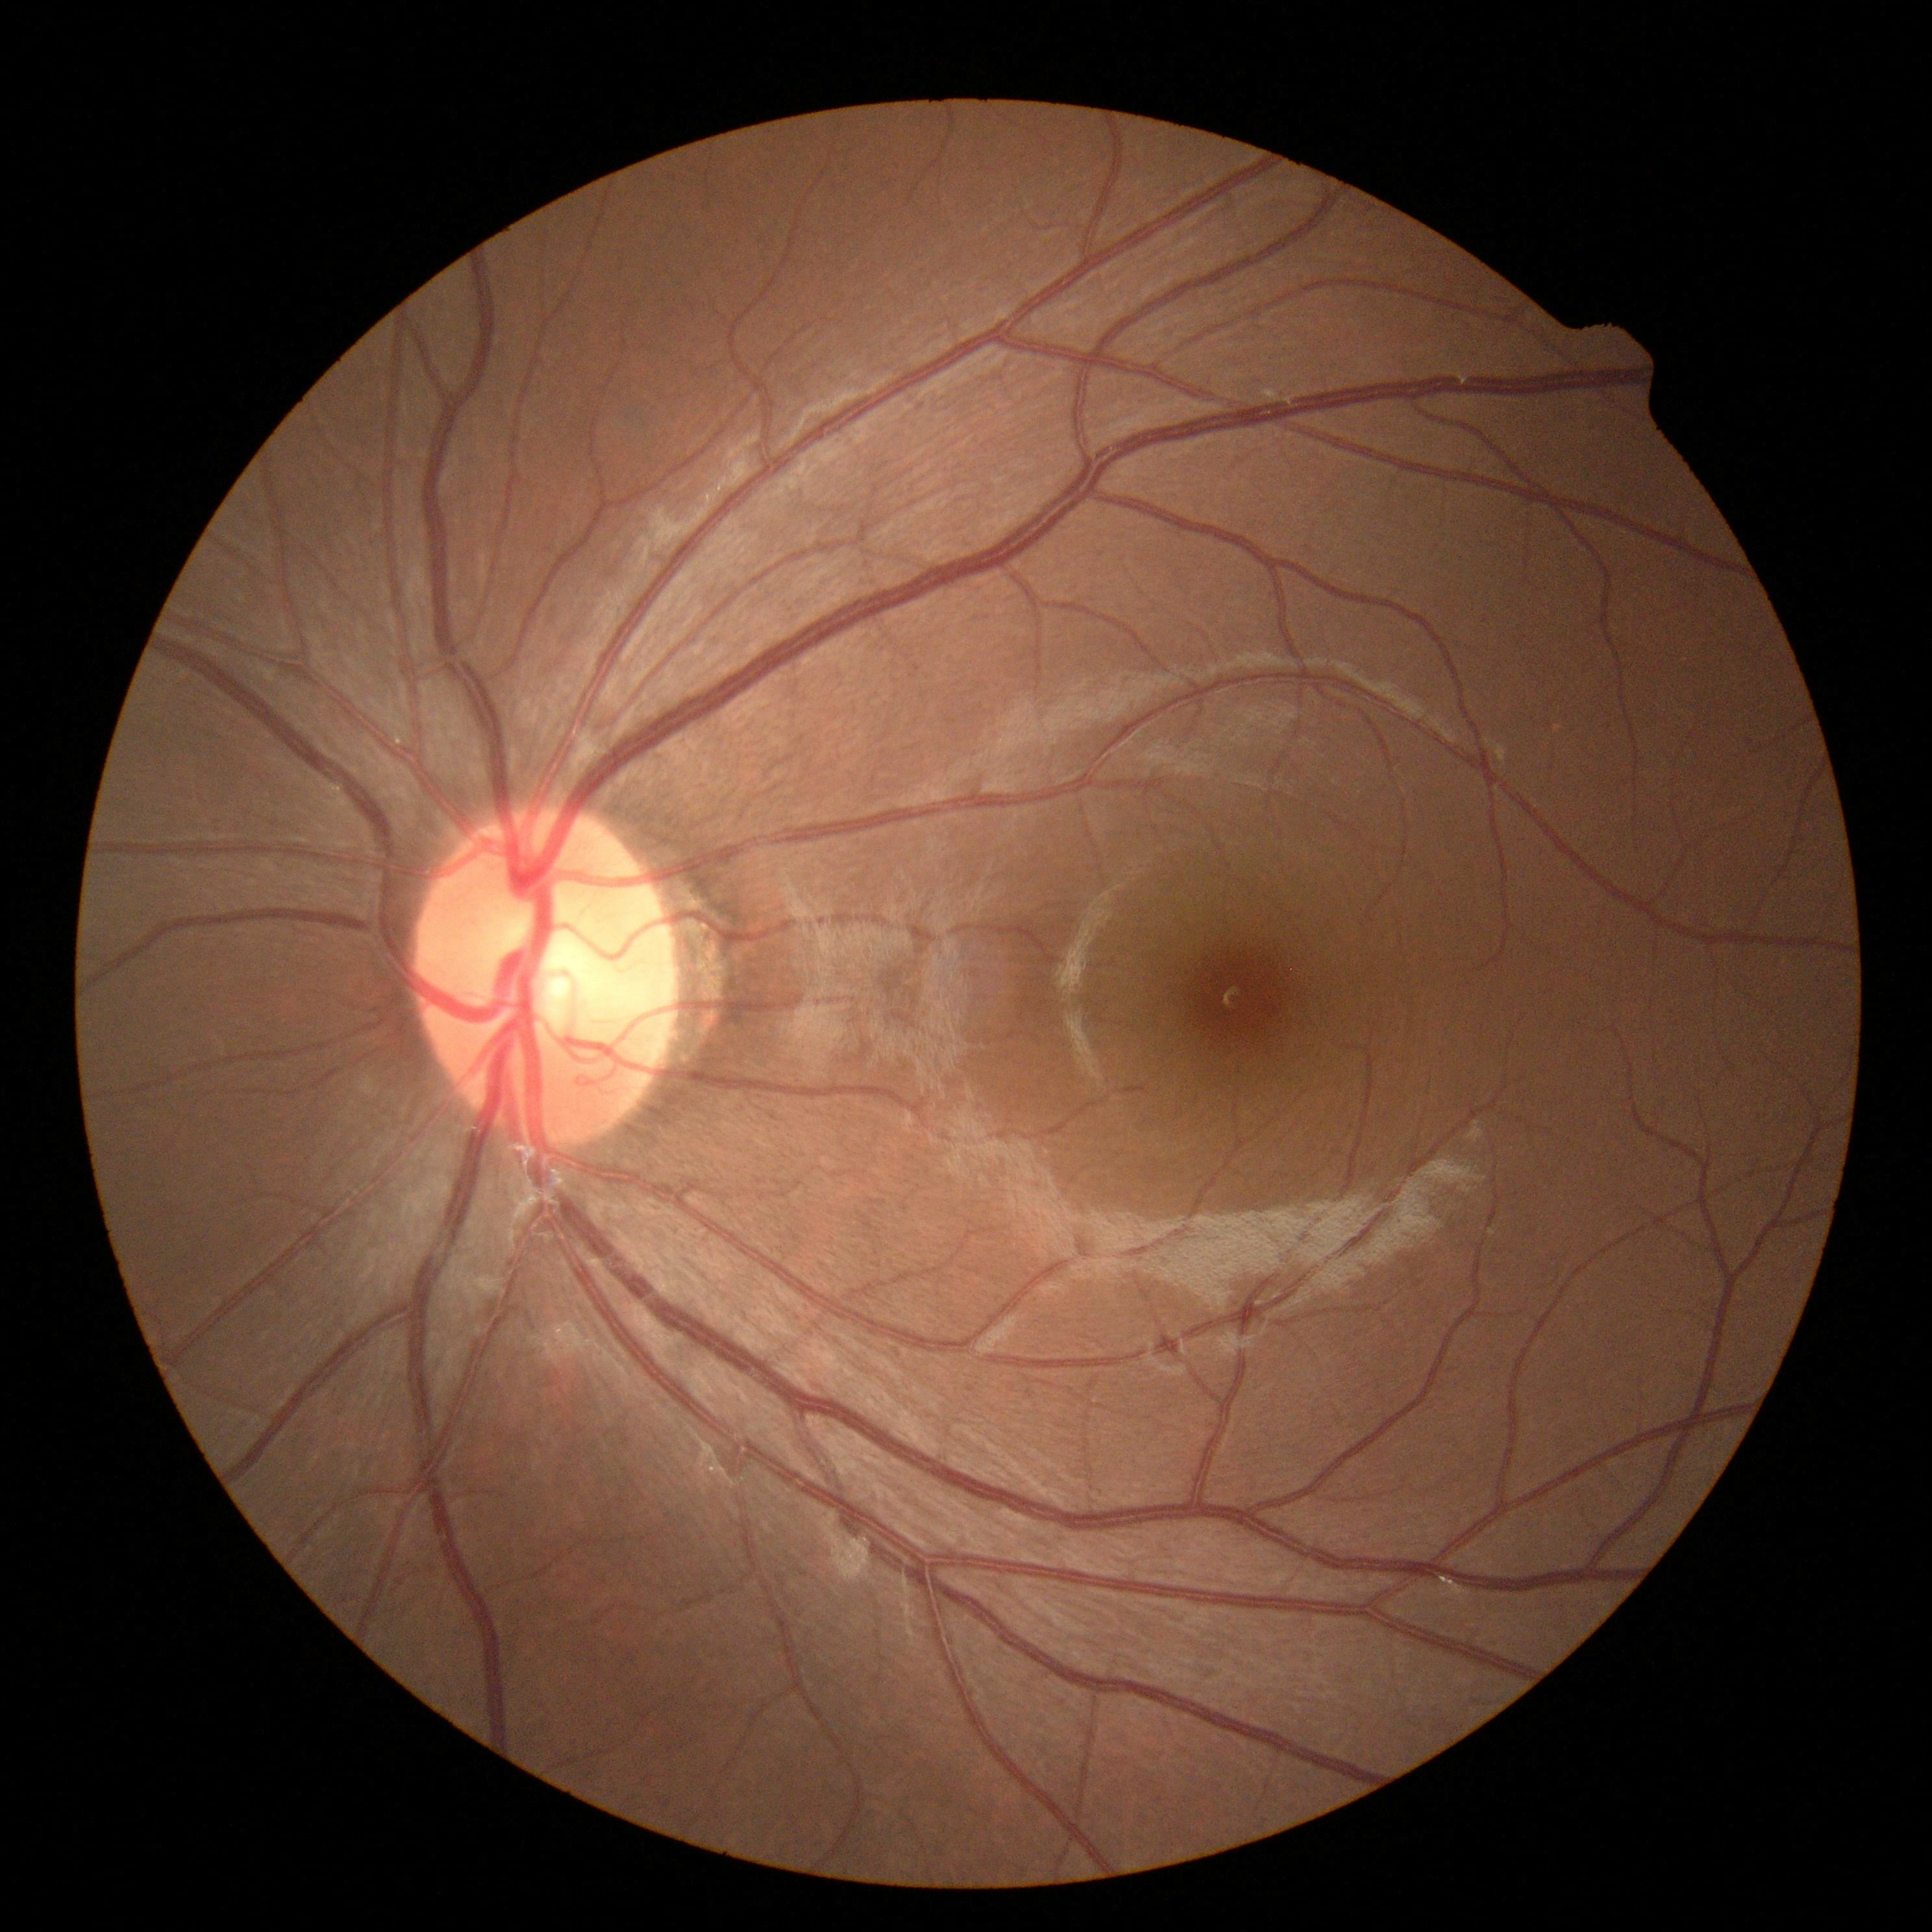

DR severity: grade 0 (no apparent retinopathy).